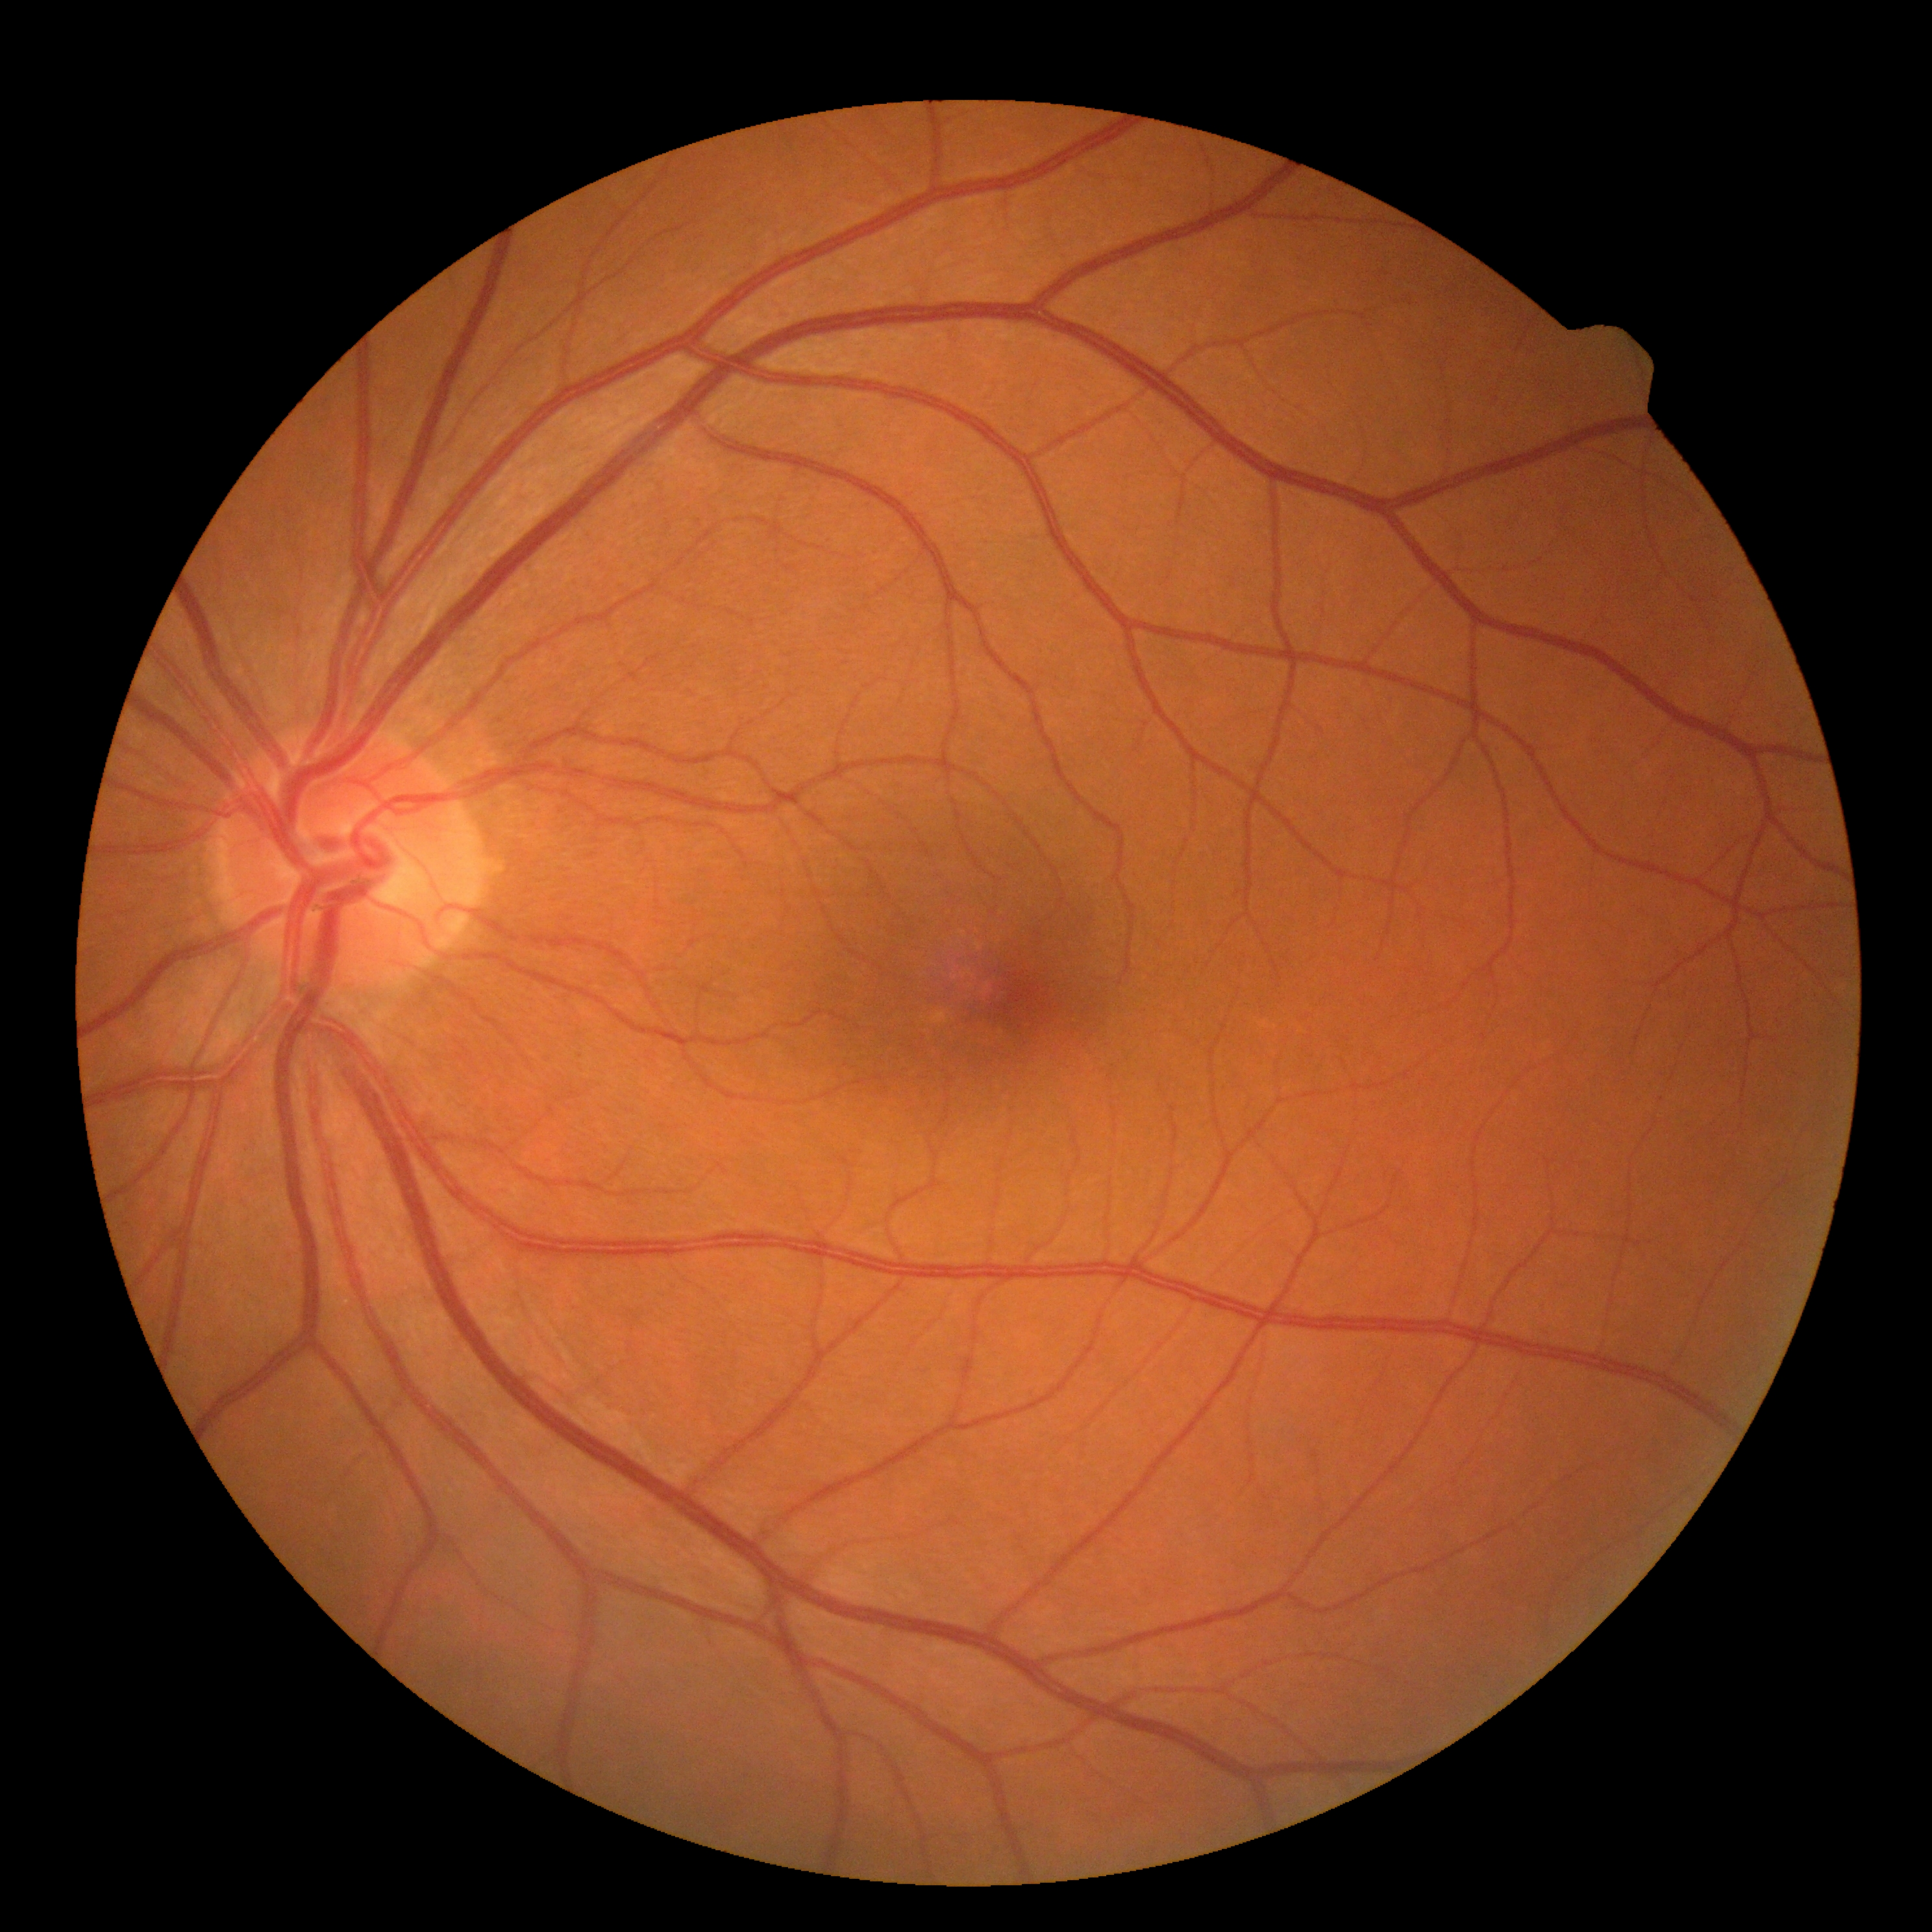
Diabetic retinopathy: no apparent diabetic retinopathy (grade 0) — no visible signs of diabetic retinopathy.
No apparent diabetic retinopathy.